45-degree field of view — 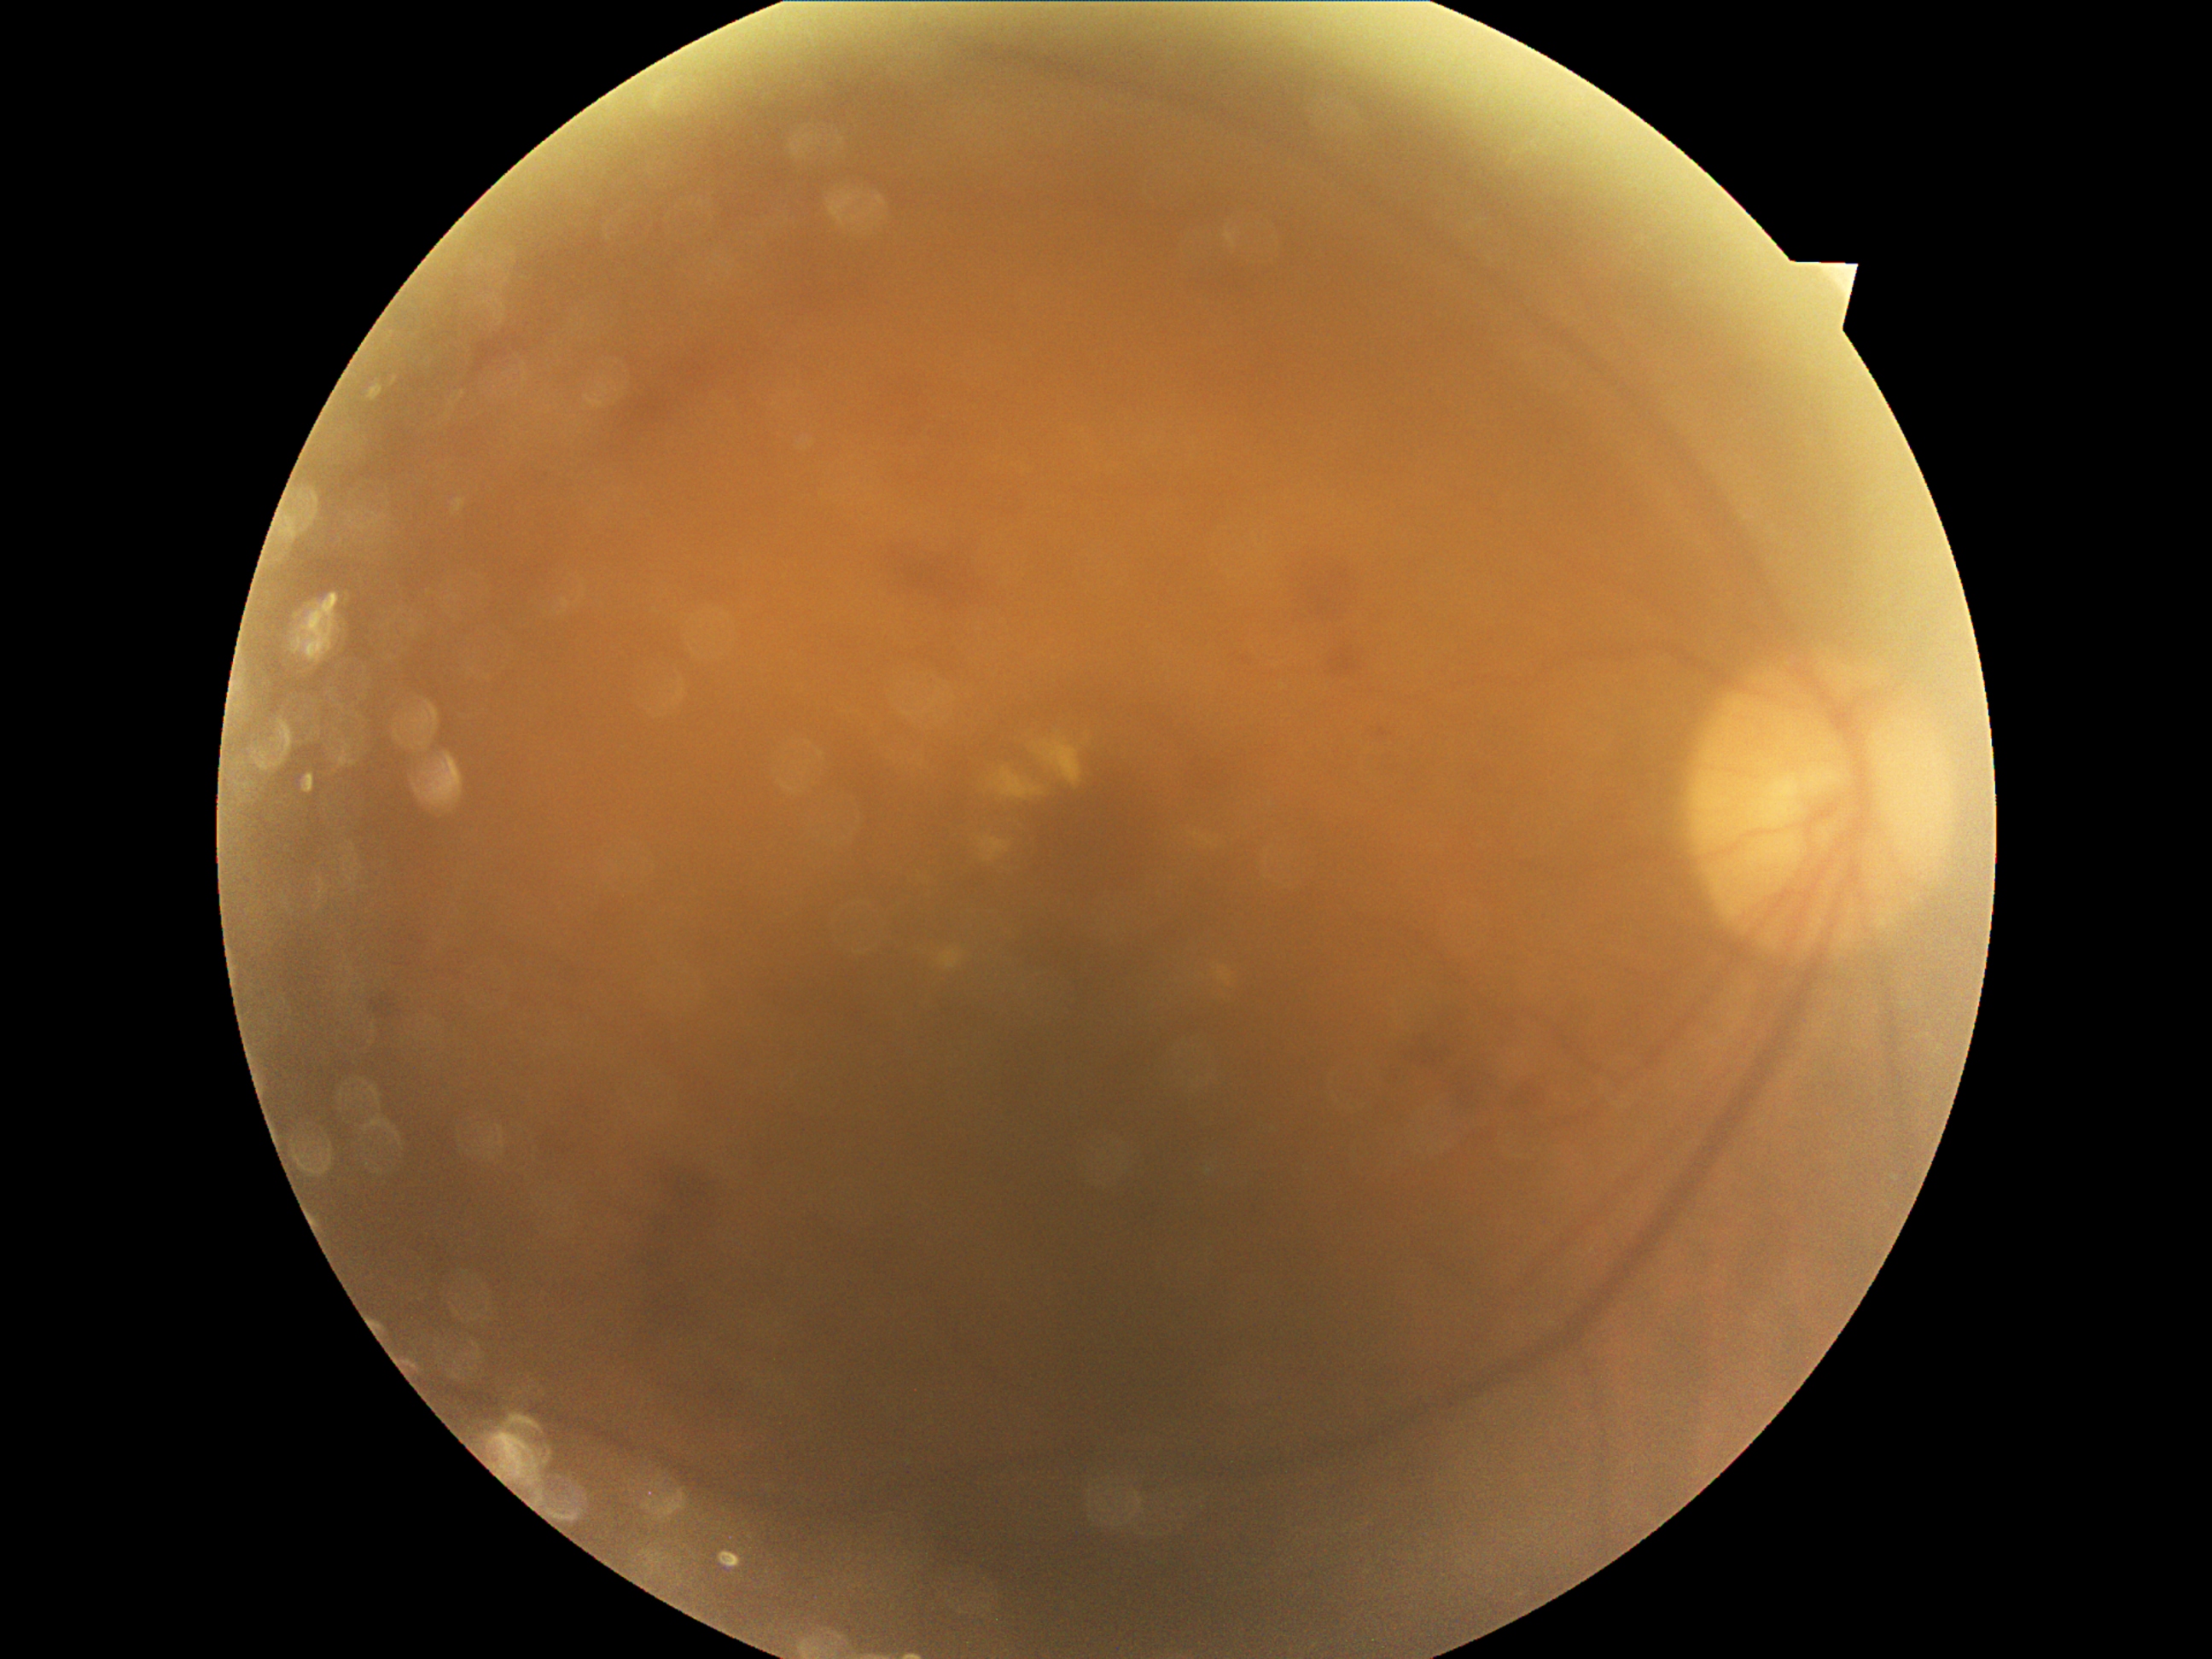 Diabetic retinopathy: moderate non-proliferative diabetic retinopathy (grade 2) — more than just microaneurysms but less than severe NPDR.